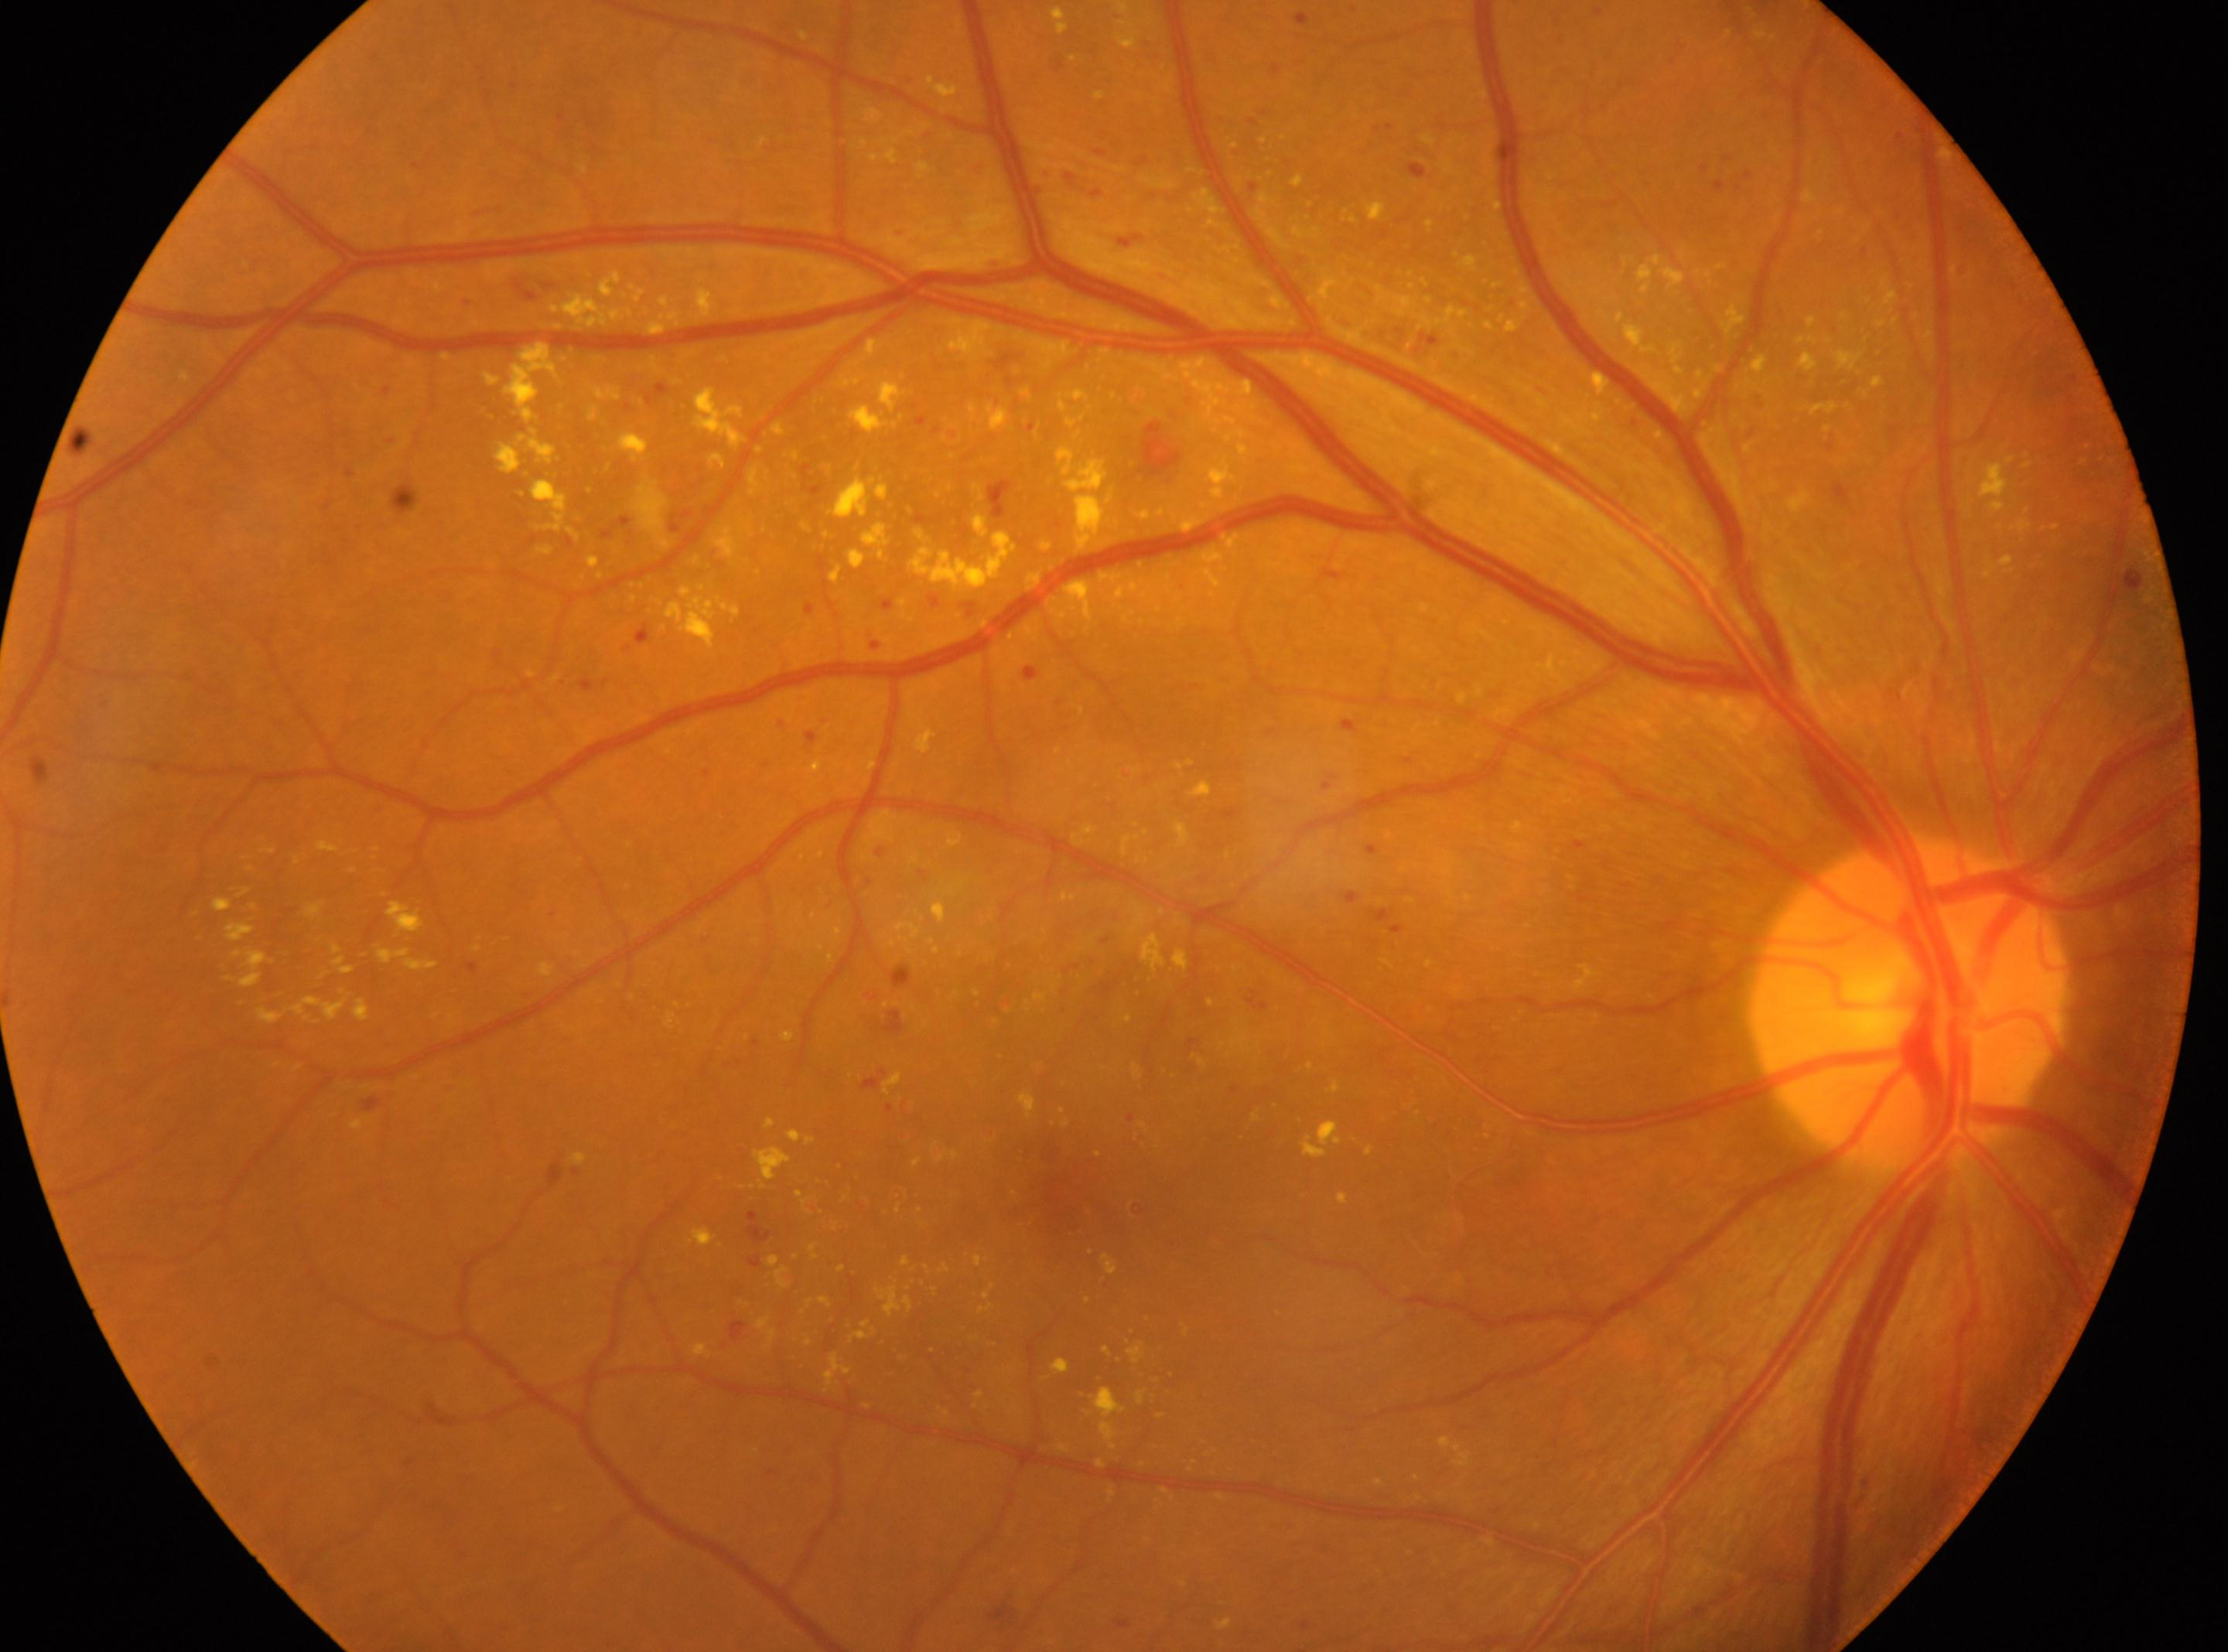
eye: right eye
optic_disc: x=1908, y=998
dr_grade: 2 — more than just microaneurysms but less than severe NPDR
fovea: x=1071, y=1197